848x848, nonmydriatic fundus photograph:
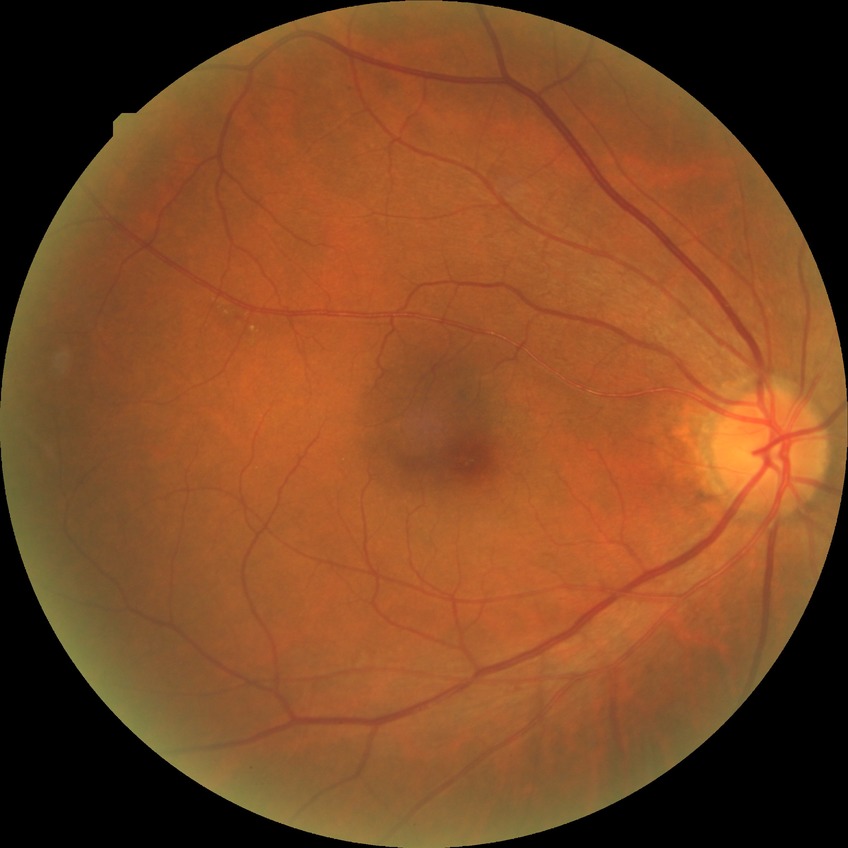
Diabetic retinopathy (DR) is simple diabetic retinopathy (SDR).